1240 x 1240 pixels. Phoenix ICON wide-field infant fundus image:
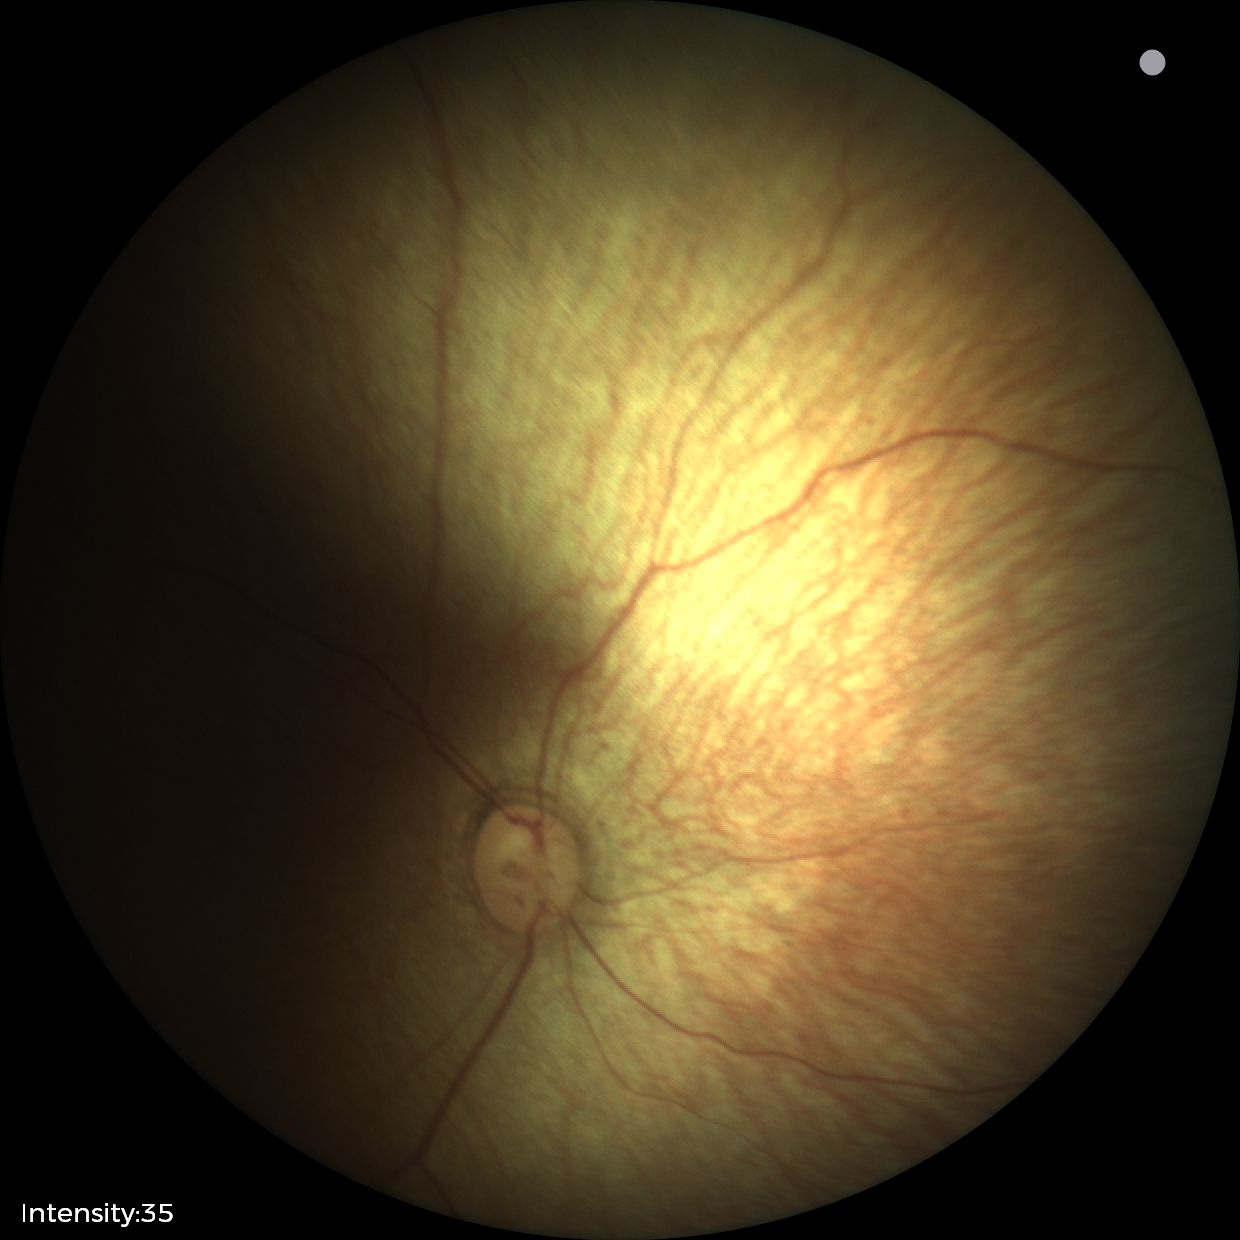

Examination with physiological retinal findings.